1440x1080px; wide-field fundus photograph of an infant: 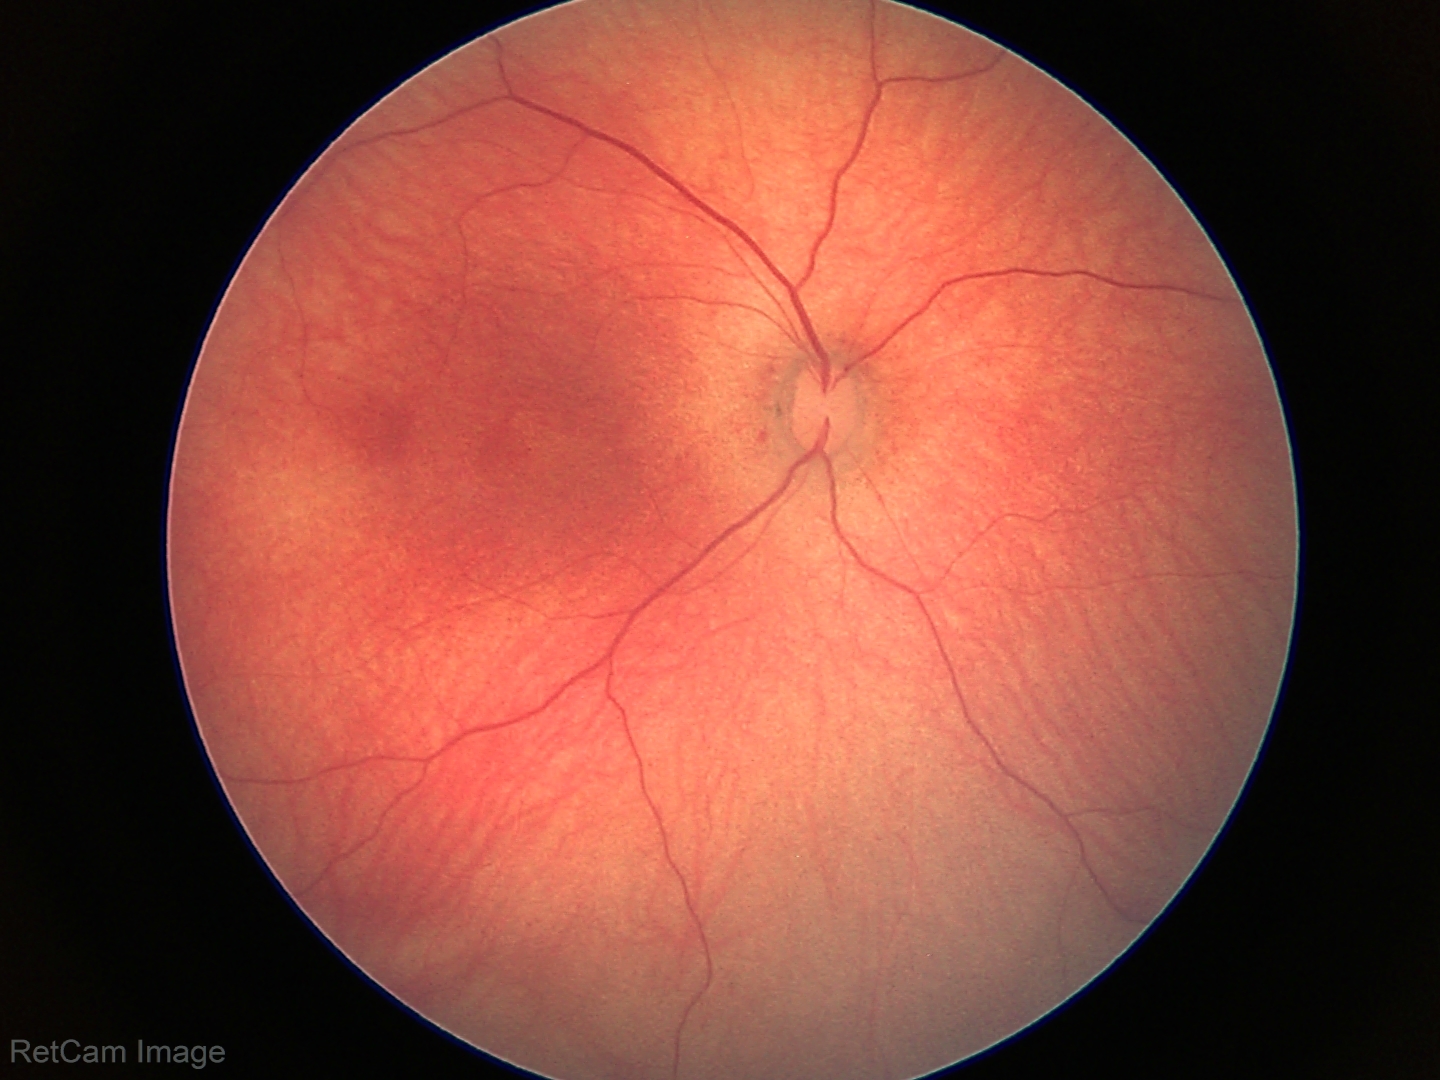

Screening examination with no abnormal retinal findings.